Without pupil dilation:
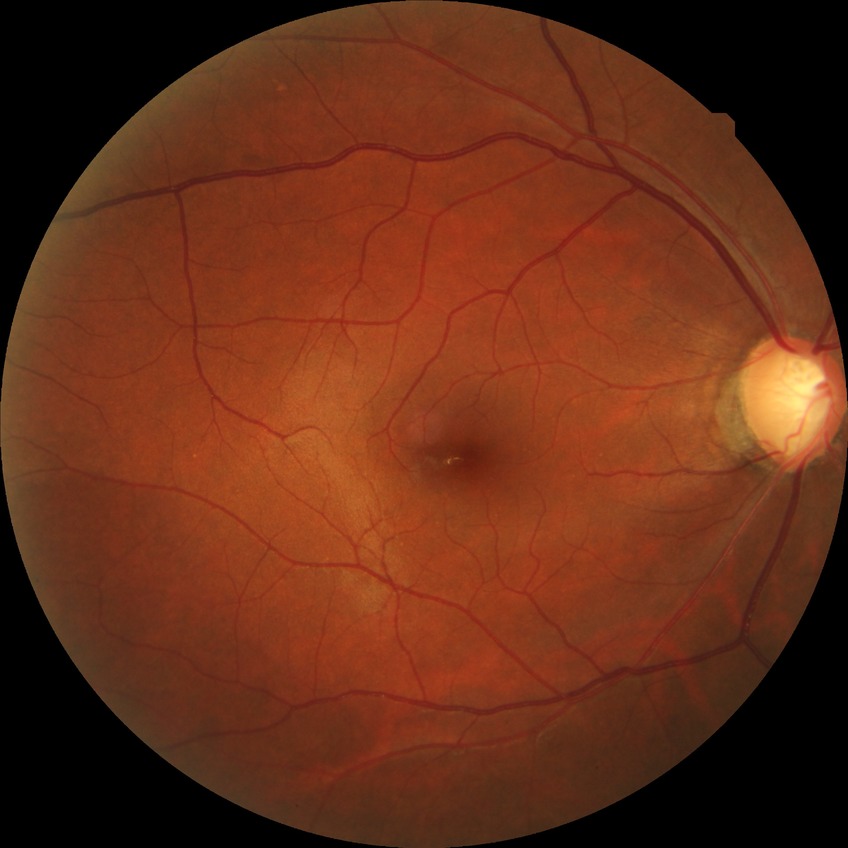
Modified Davis grade is NDR. No DR findings.